Retinal fundus photograph: 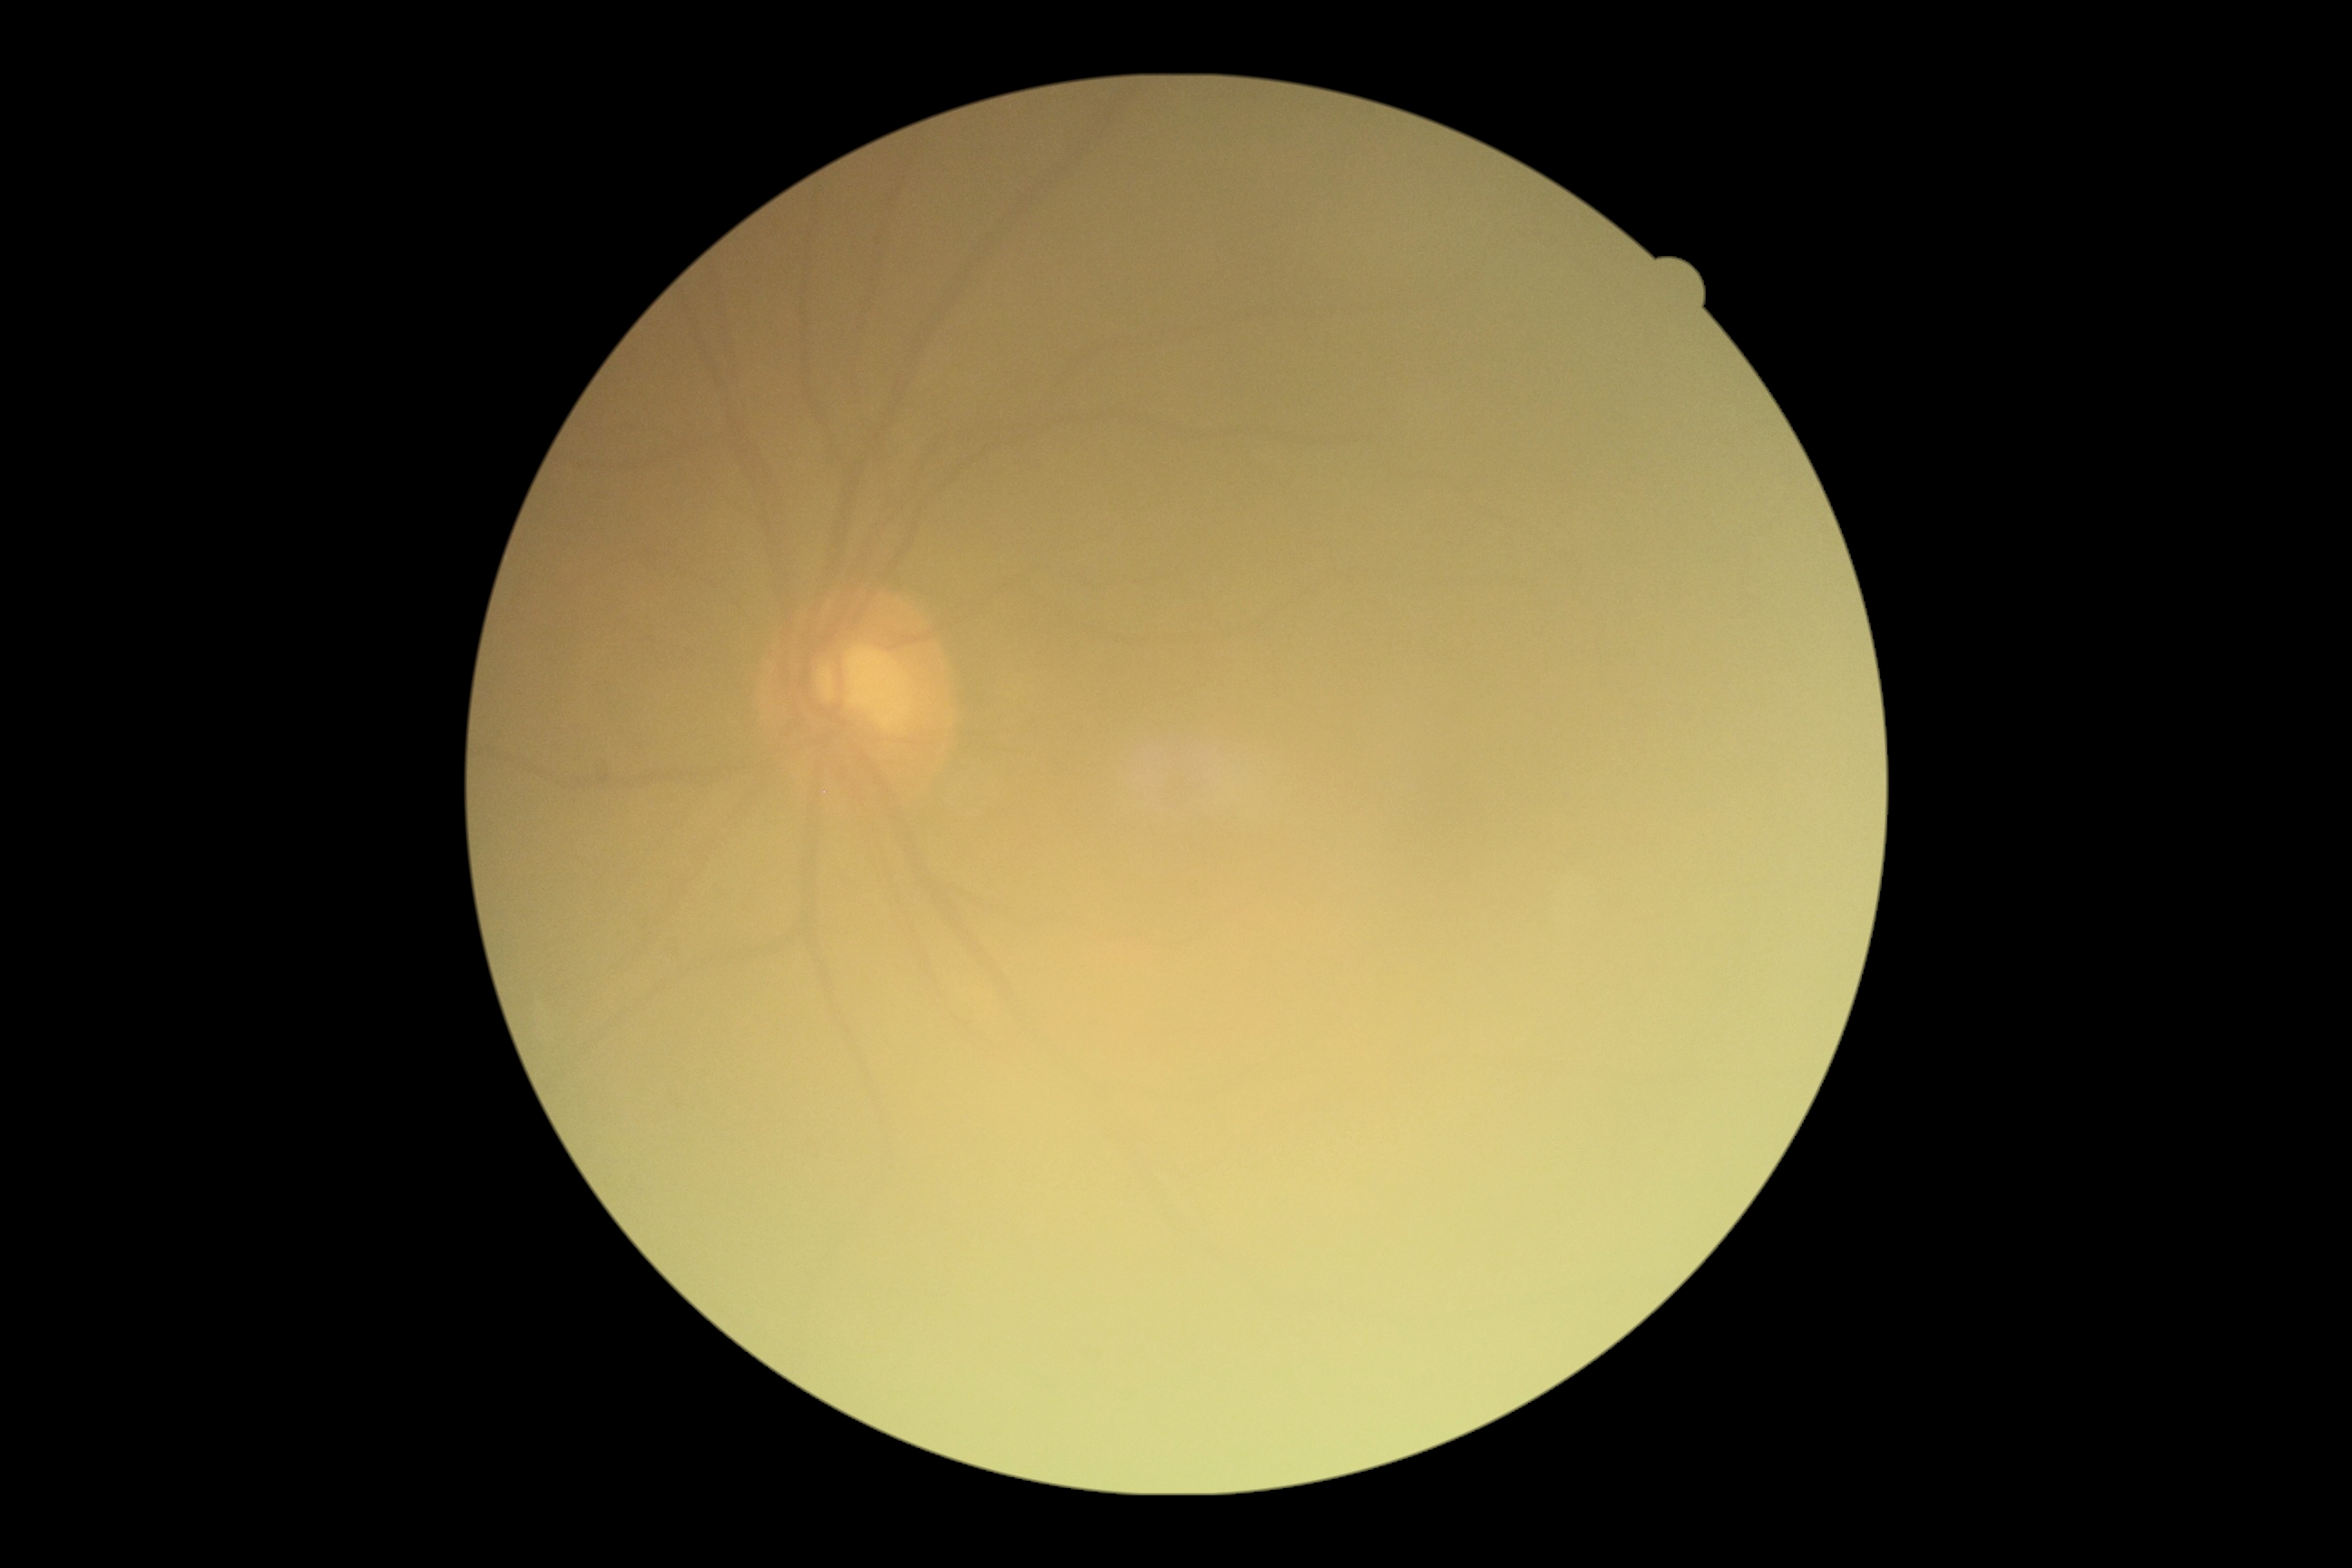
DR severity: 0.